45° field of view; modified Davis classification; 848 x 848 pixels; camera: NIDEK AFC-230: 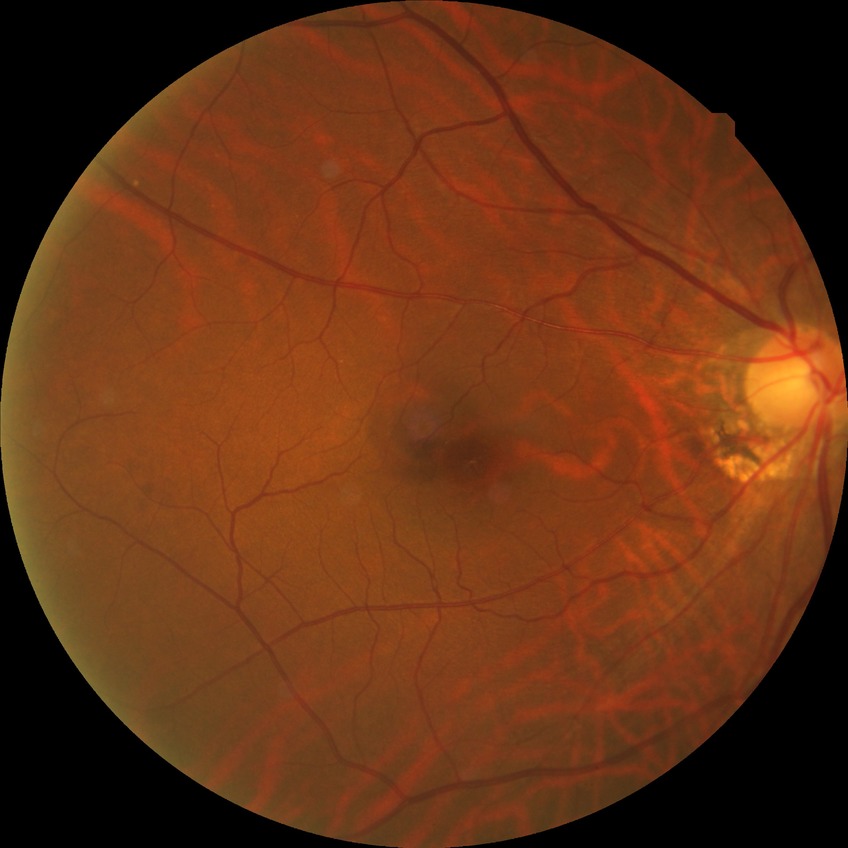
  proliferative_class: non-proliferative diabetic retinopathy
  davis_grade: SDR